45-degree field of view. 2352x1568
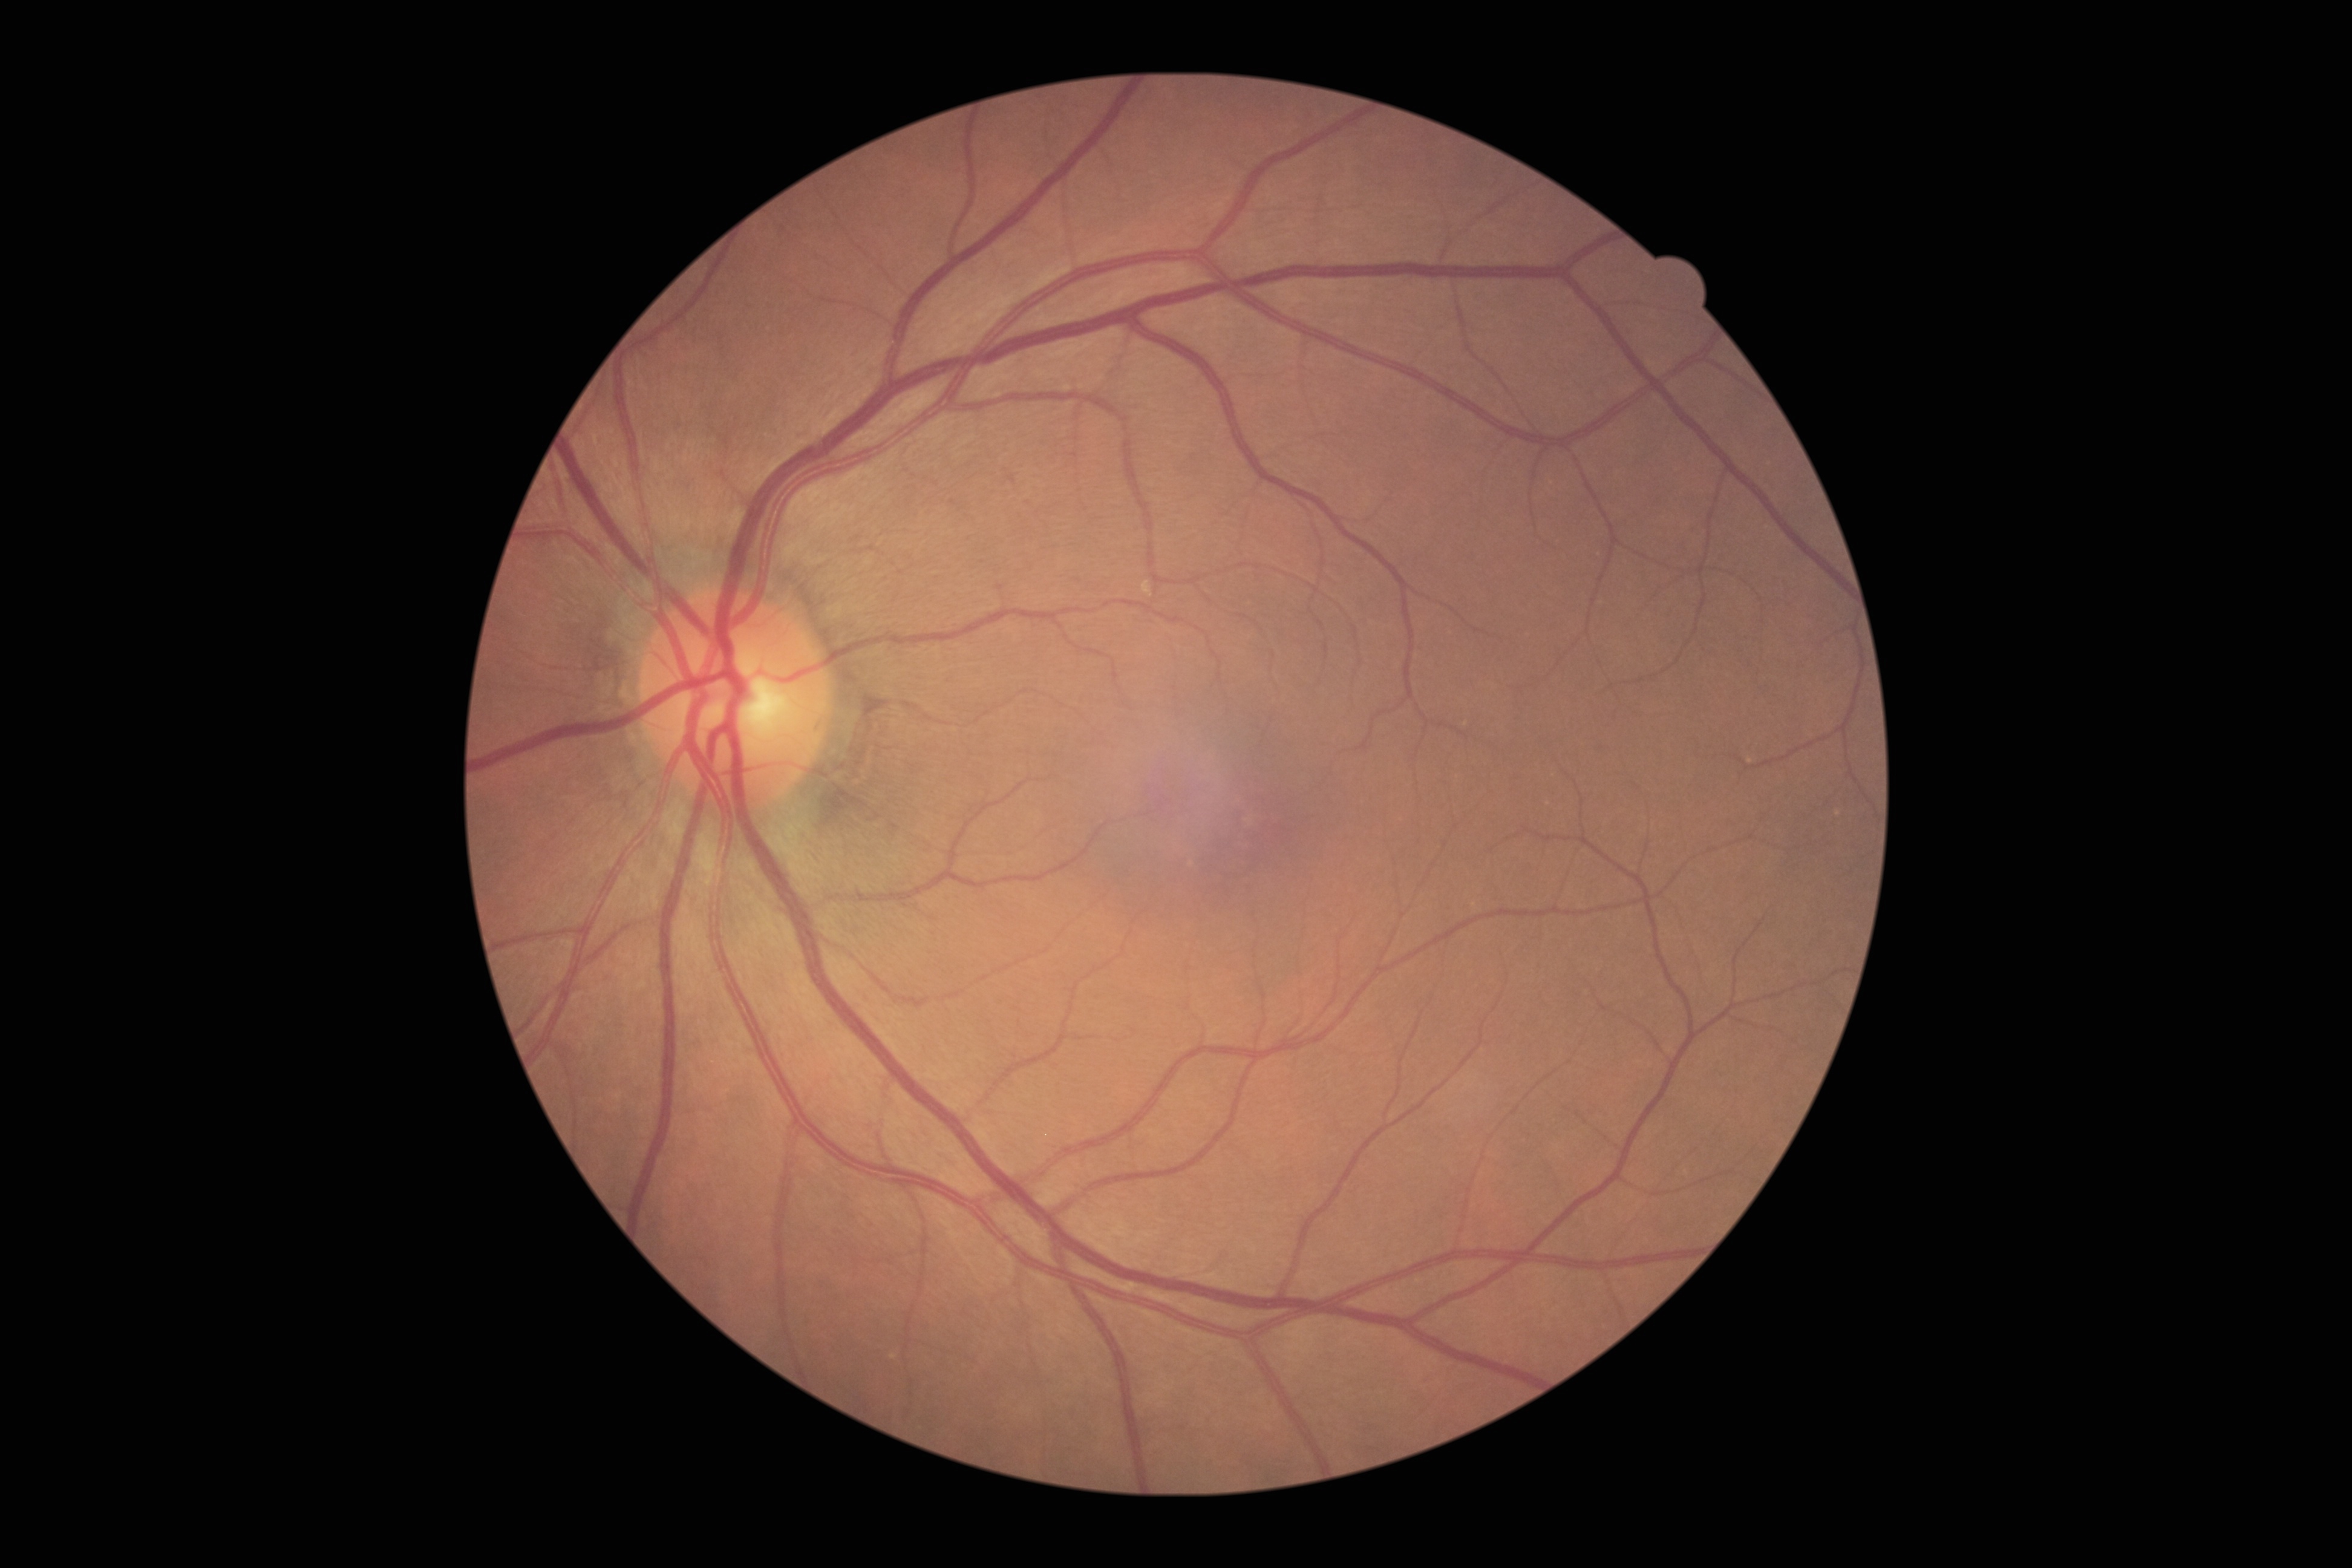

DR impression: no DR findings; diabetic retinopathy (DR): no apparent diabetic retinopathy (grade 0).